1240x1240px; camera: Phoenix ICON (100° FOV); wide-field fundus photograph of an infant
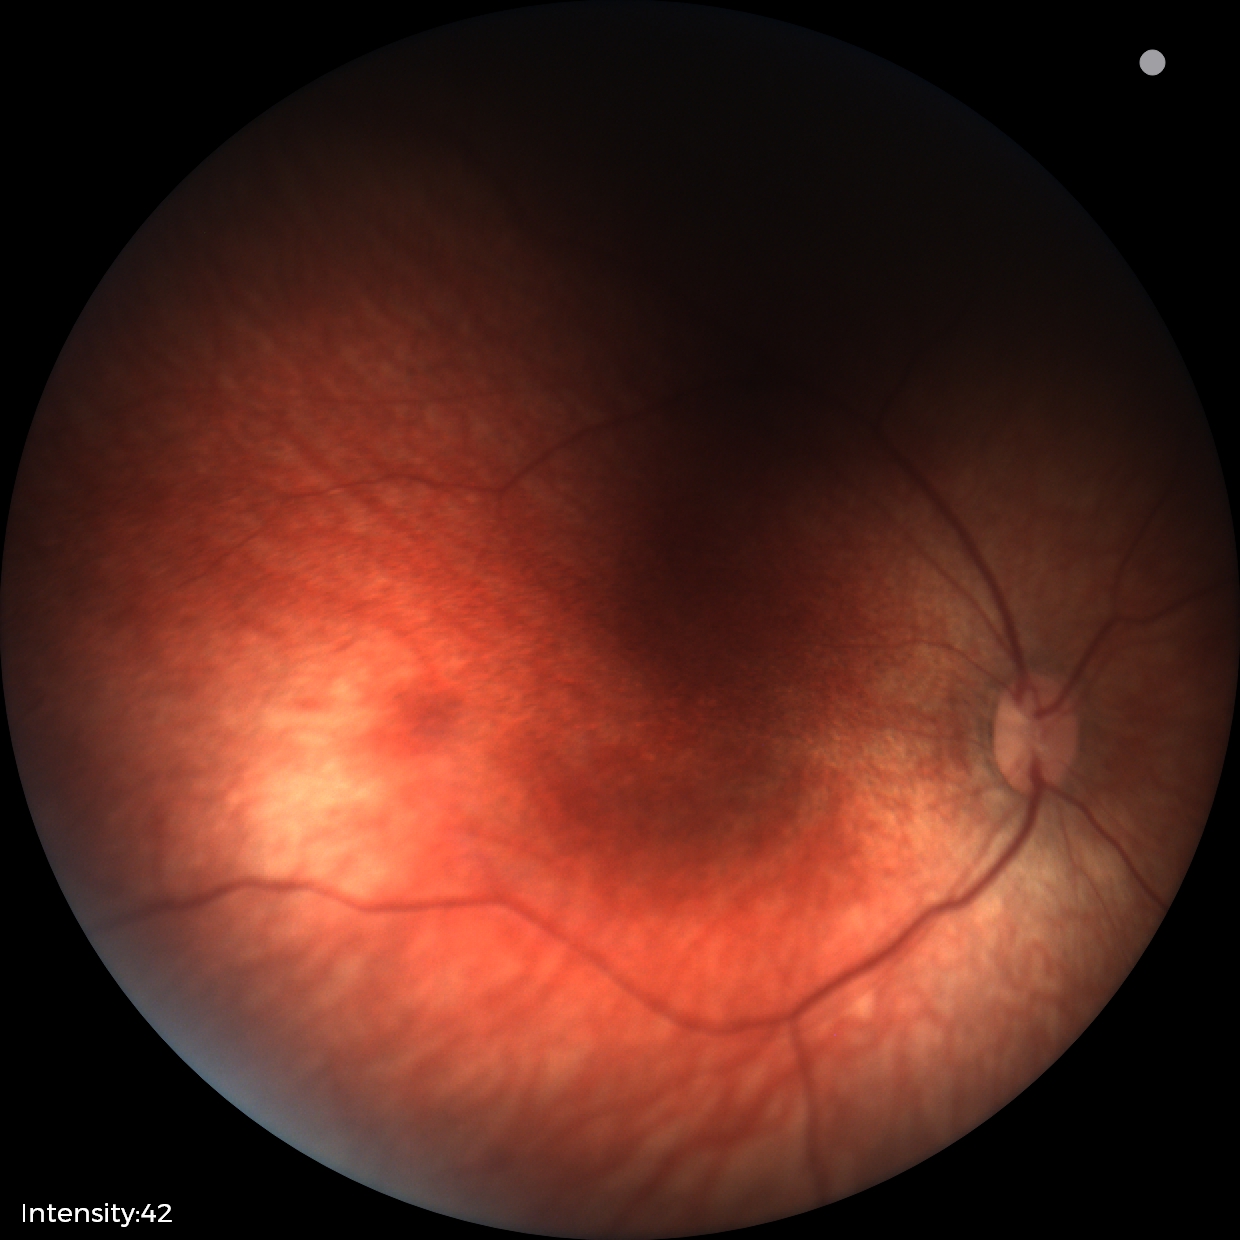 No retinal pathology identified on screening.